RetCam wide-field infant fundus image. 640x480
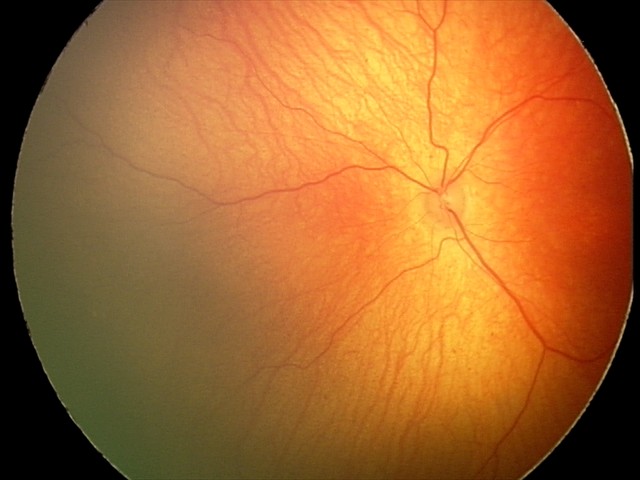

Normal screening examination.